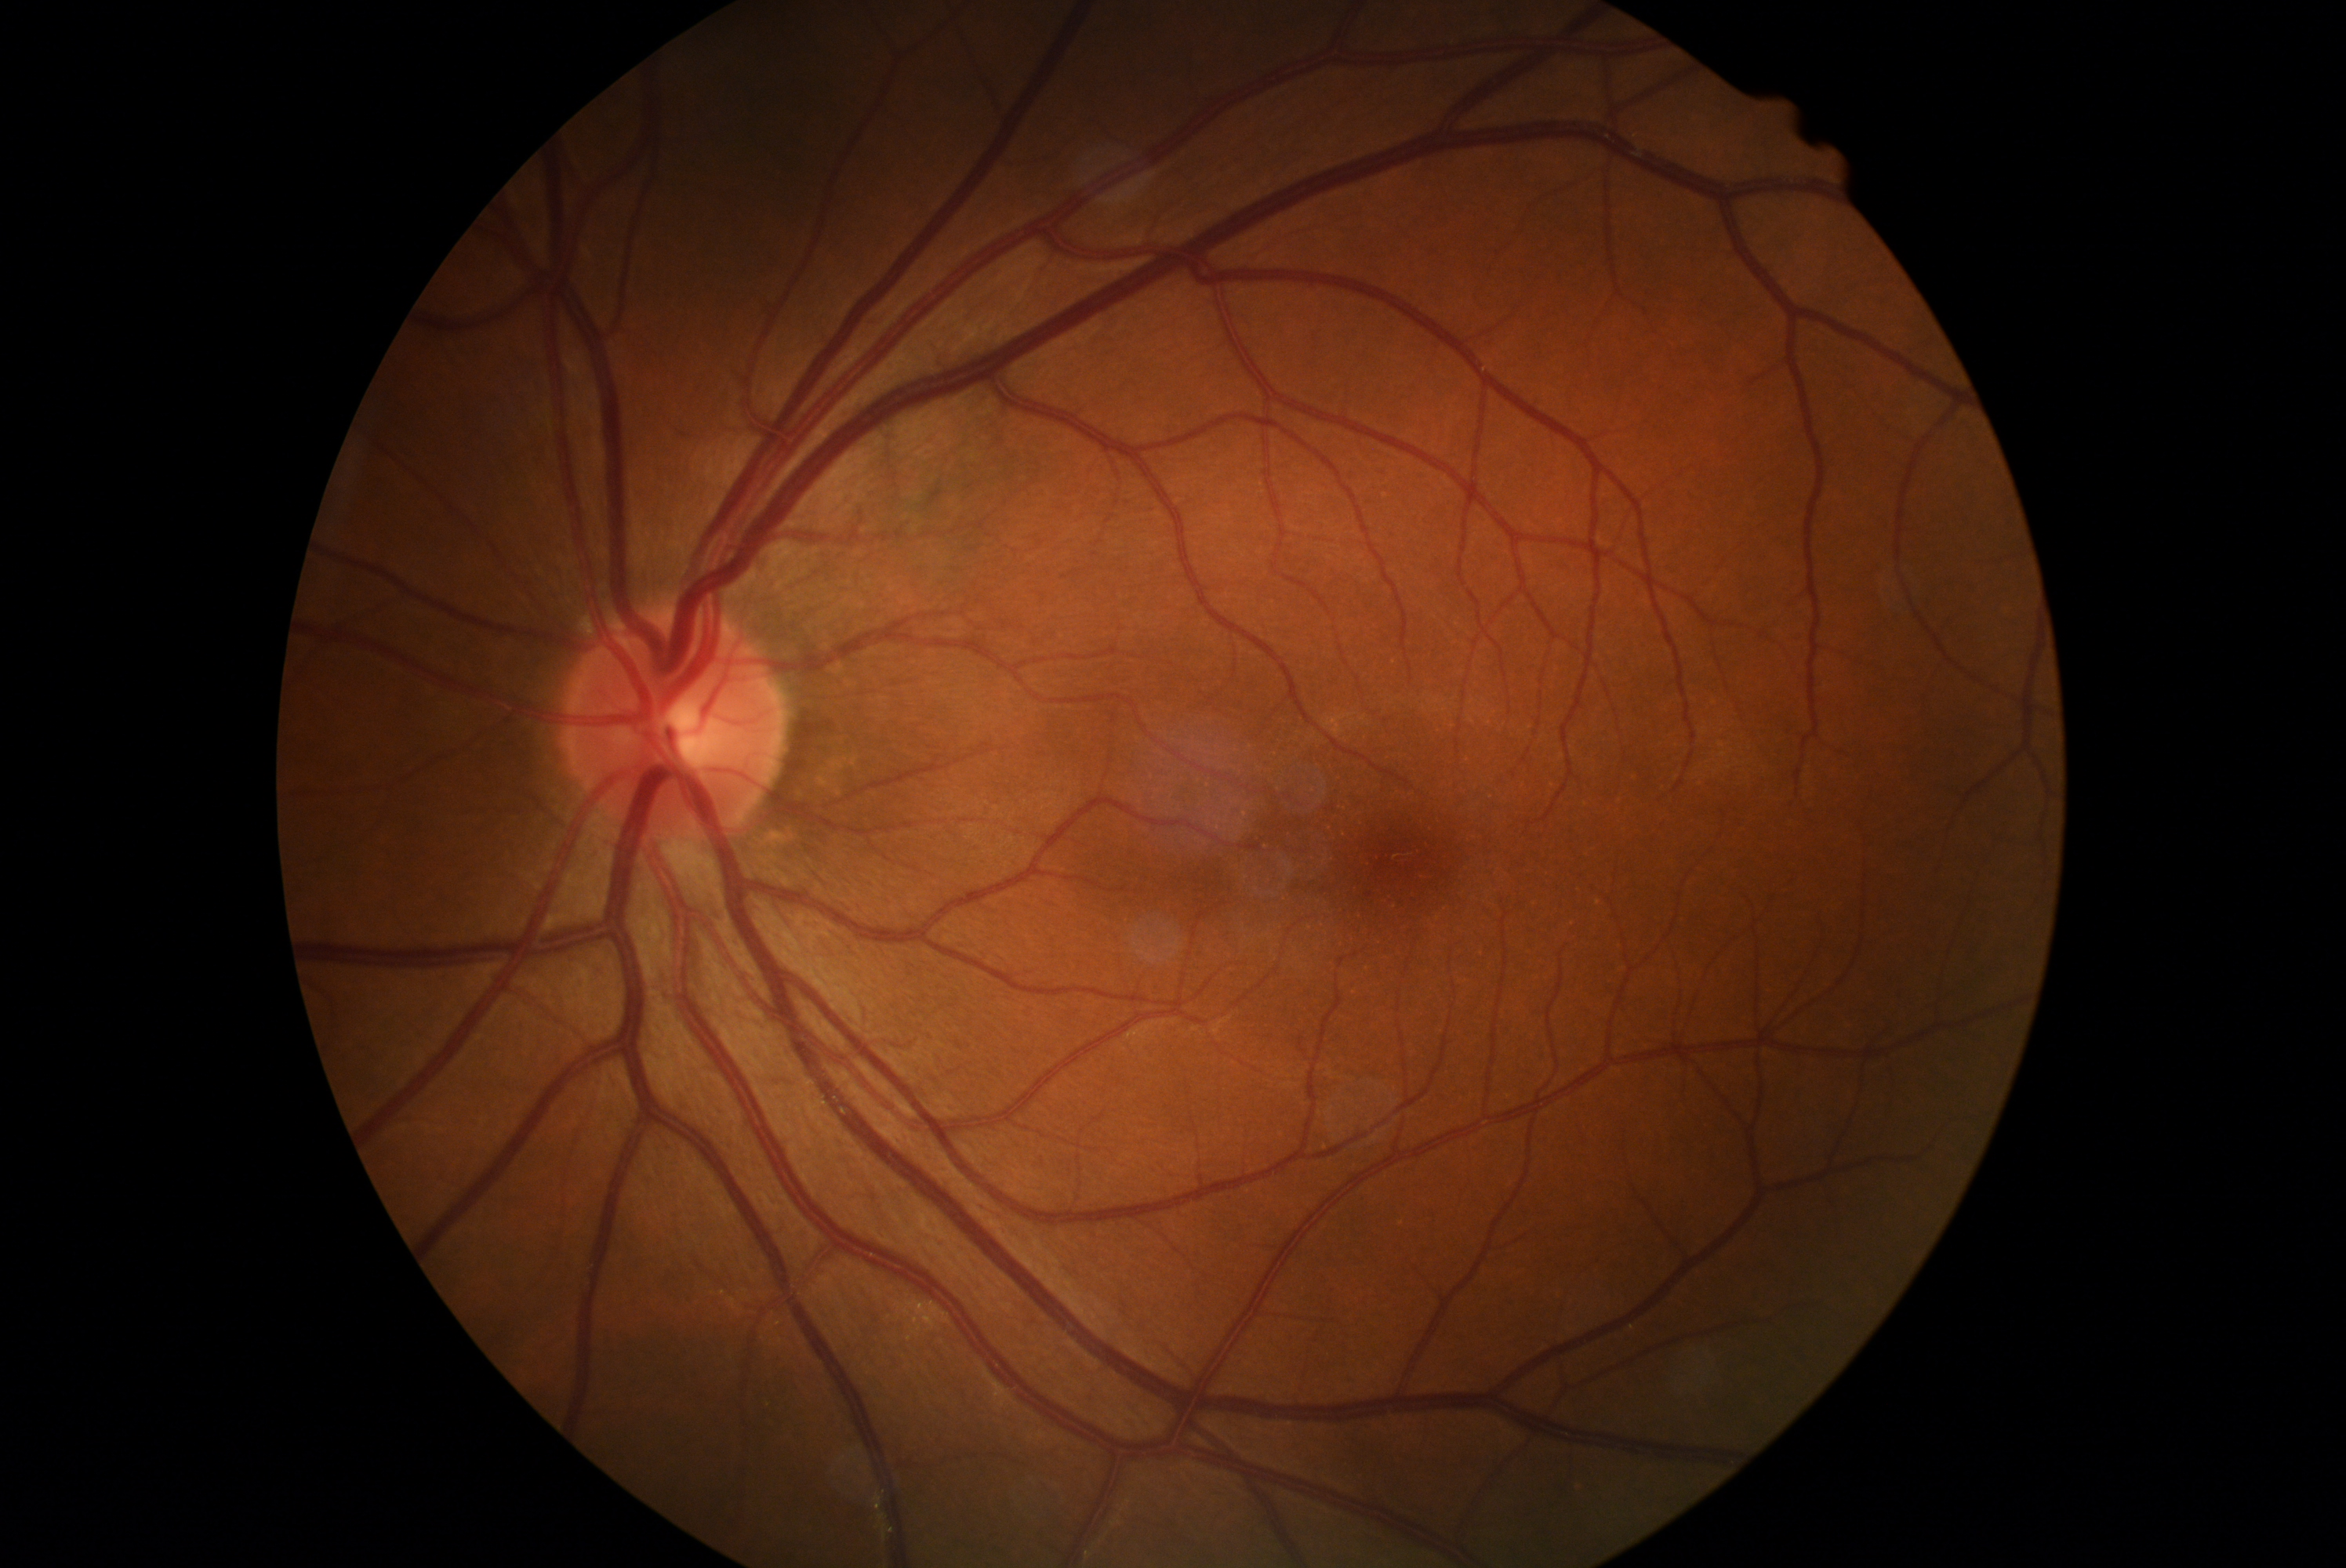 diabetic retinopathy grade: no apparent diabetic retinopathy (0)
DR impression: no signs of DR